Color fundus image.
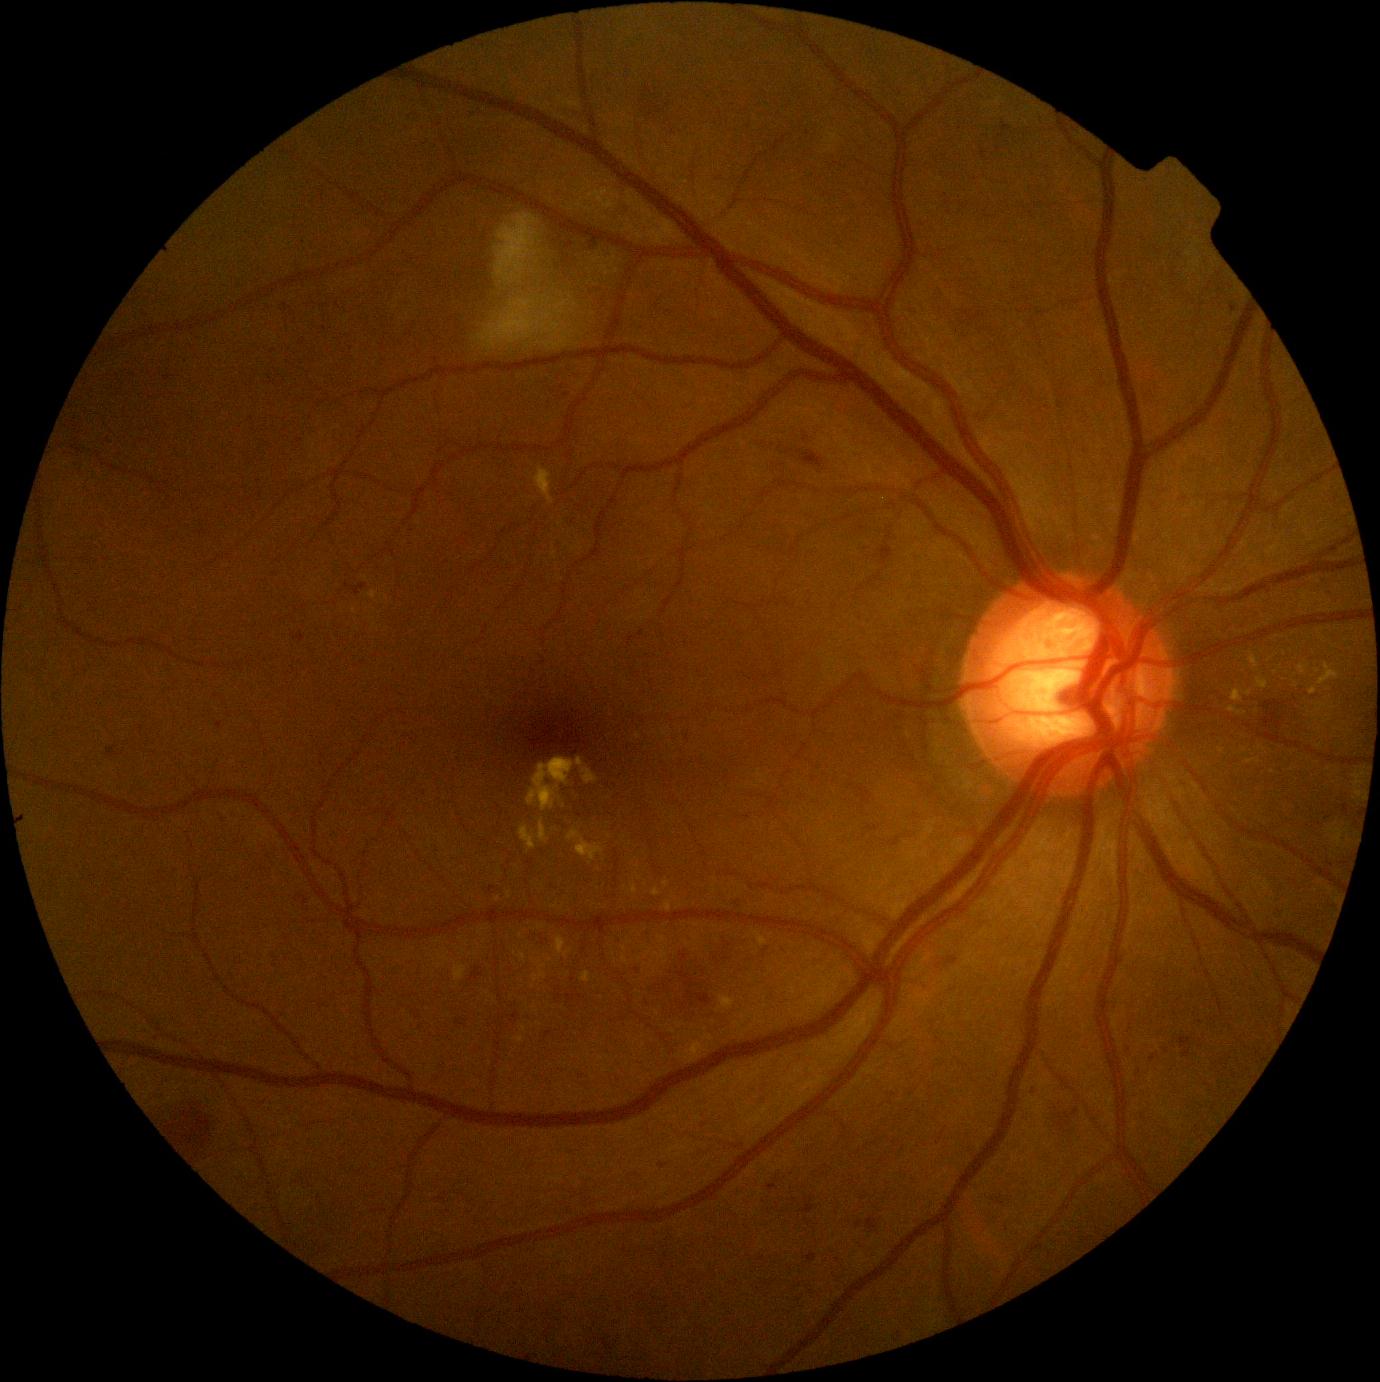

DR is moderate NPDR (grade 2)
Selected lesions:
EXs (subset) = 535, 467, 555, 506; 520, 826, 536, 850; 652, 888, 661, 896; 721, 996, 735, 1010; 582, 971, 591, 984; 1298, 665, 1309, 674; 516, 1037, 524, 1043; 454, 963, 468, 981; 1243, 690, 1252, 697
EXs (small, approximate centers) near [639,877]; [560,799]; [387,599]; [549,960]; [533,960]; [1276,672]; [498,899]